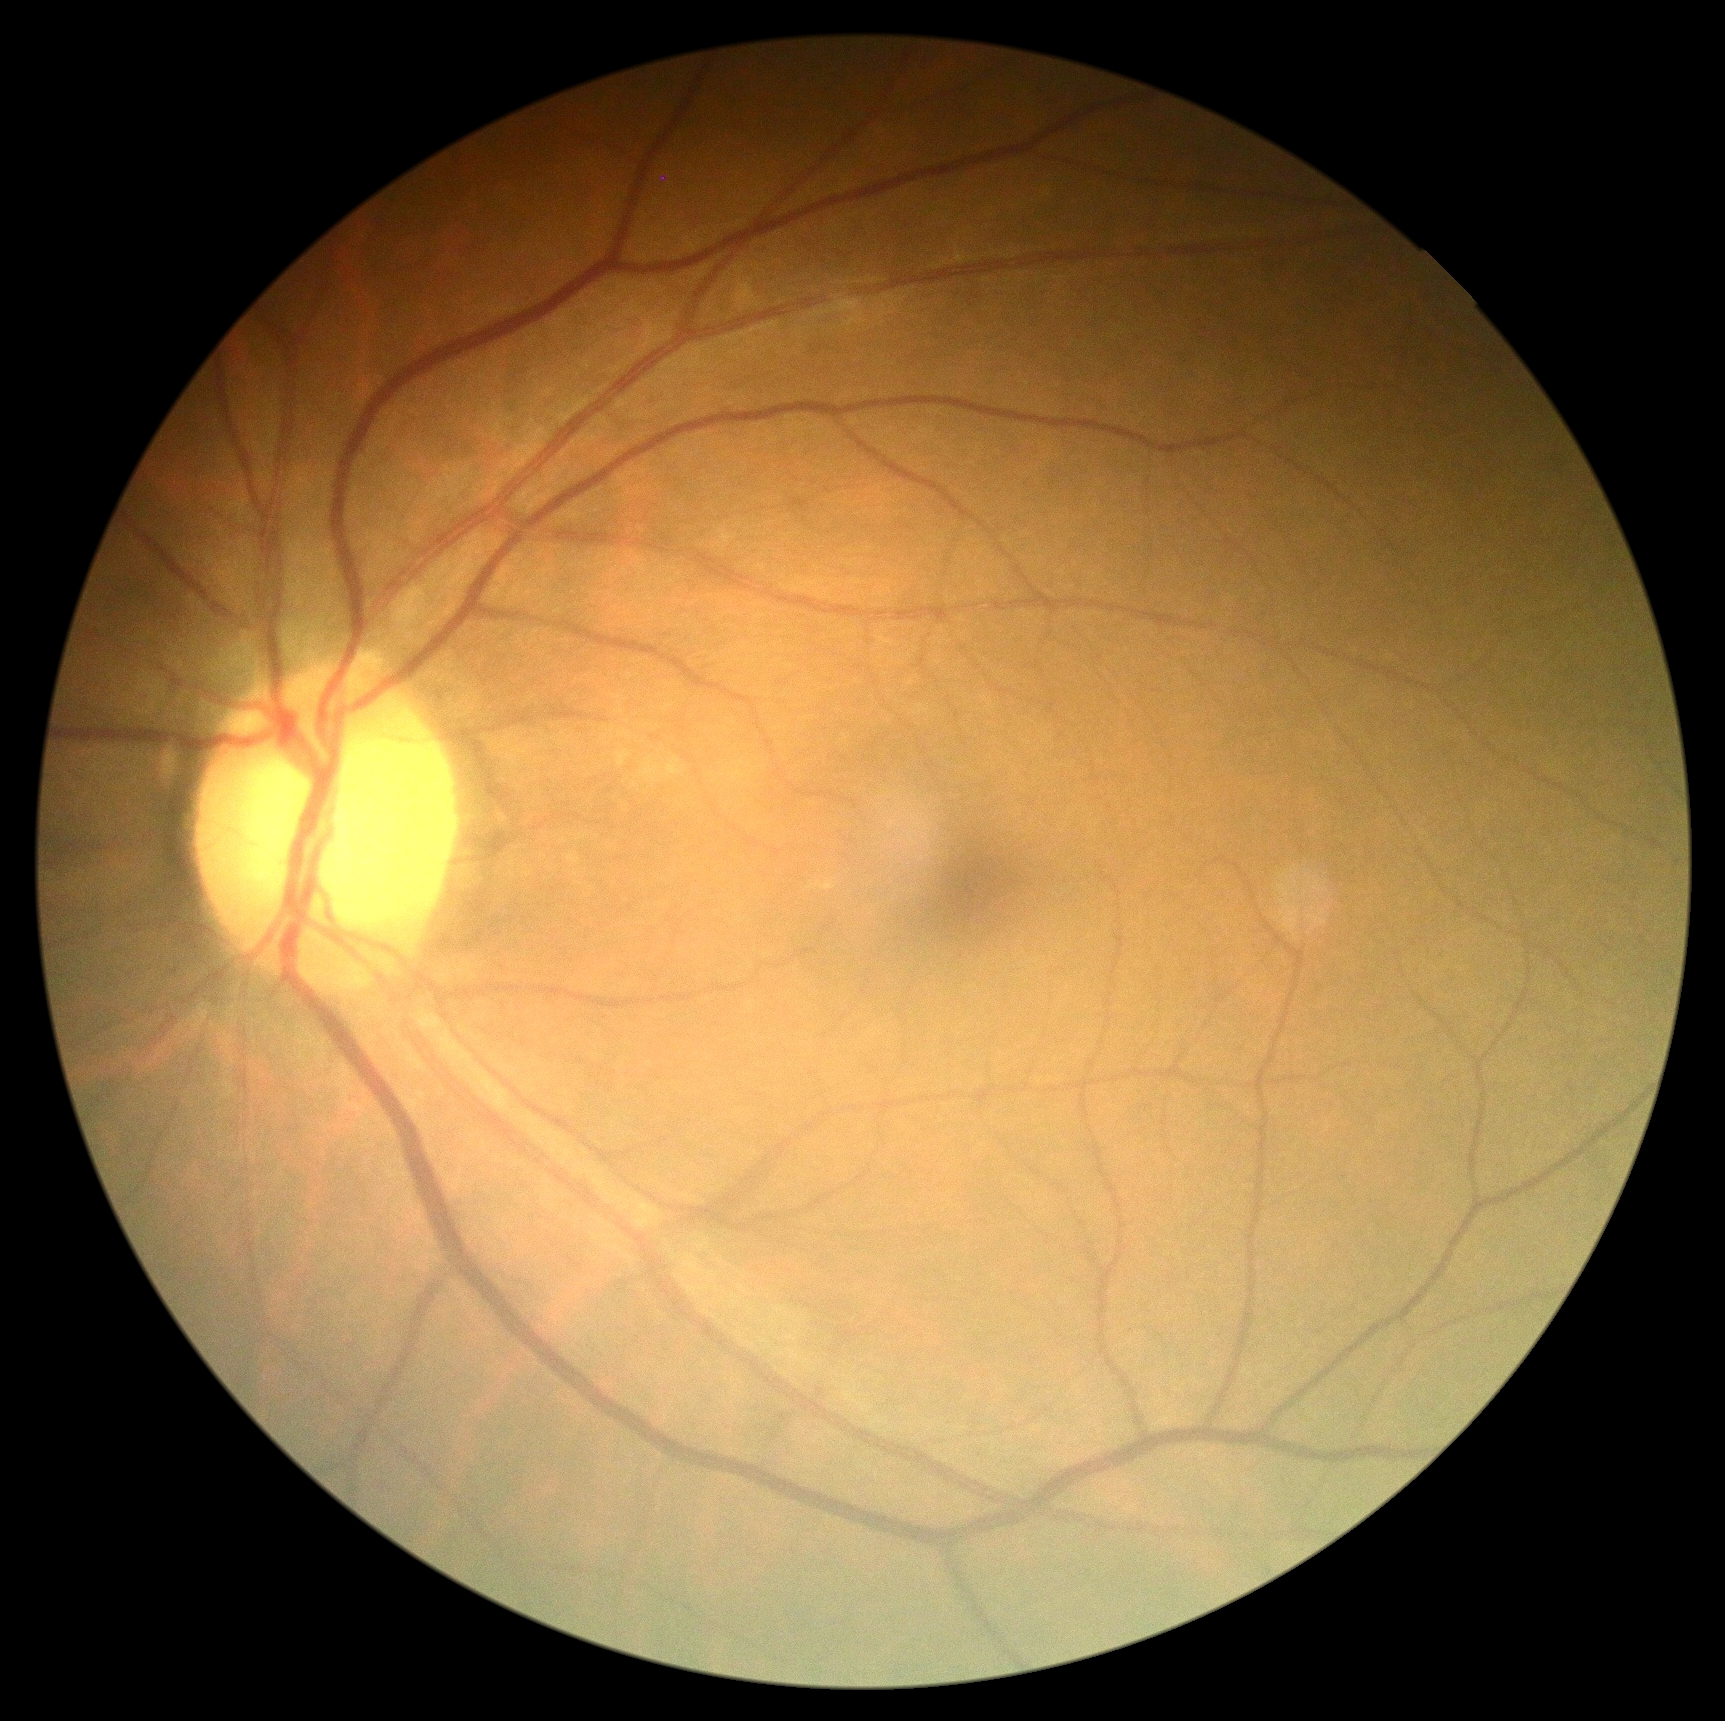 DR impression: negative for DR, diabetic retinopathy severity: grade 0 (no apparent retinopathy).